Pediatric retinal photograph (wide-field); 1240 x 1240 pixels; Phoenix ICON, 100° FOV: 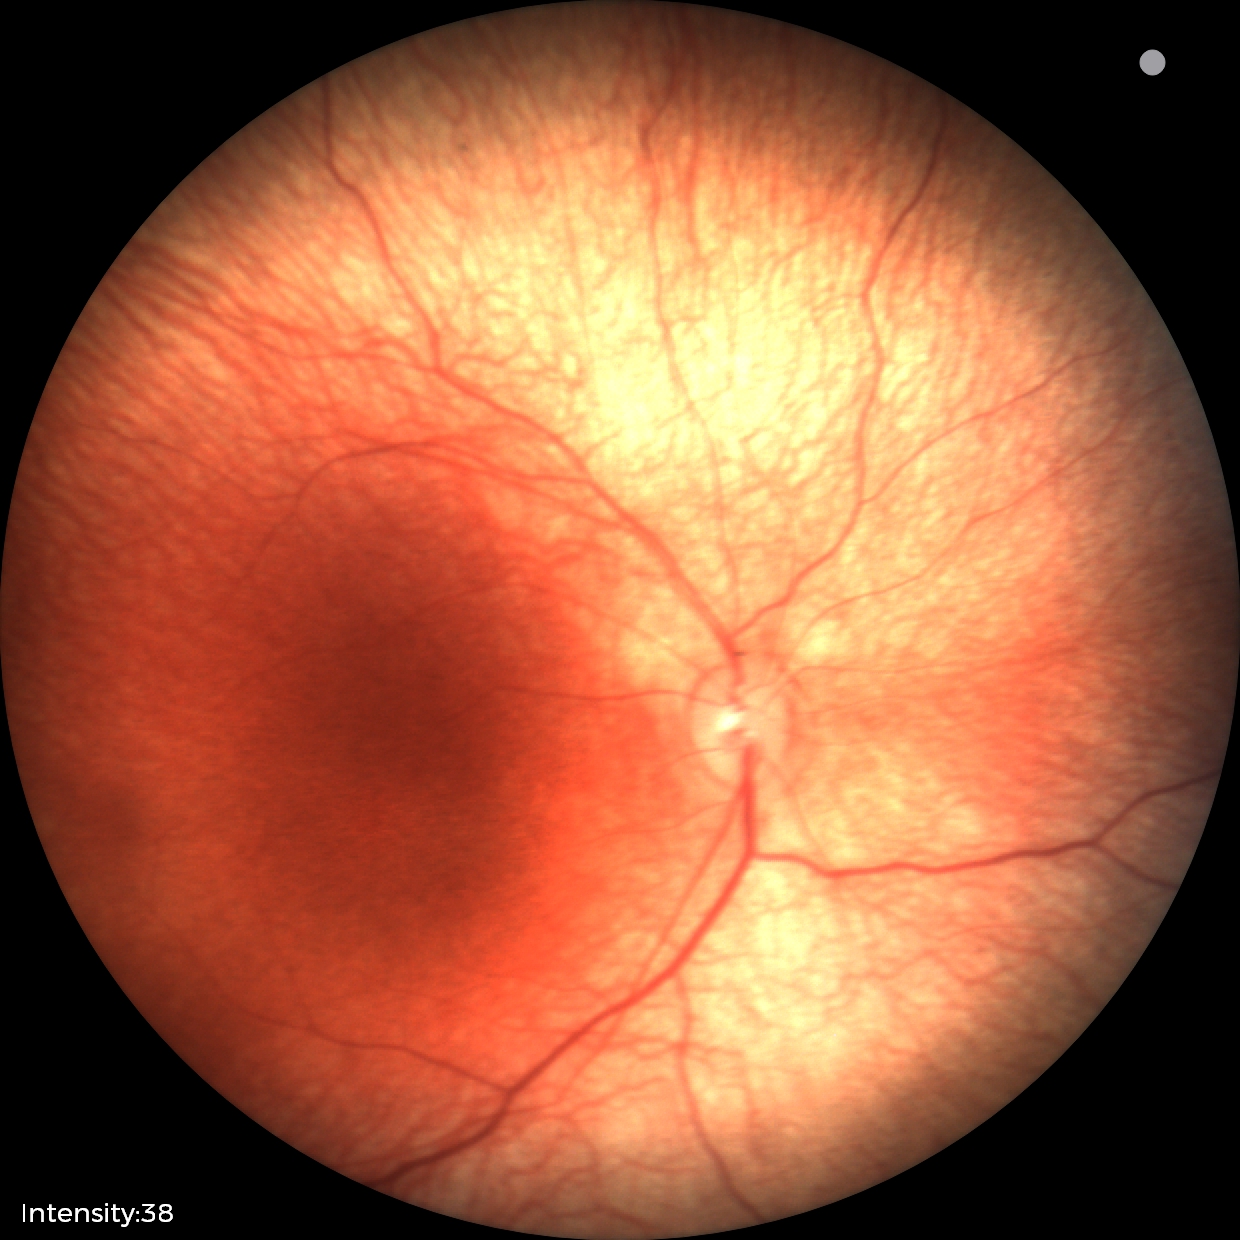
Screening examination with no abnormal retinal findings.